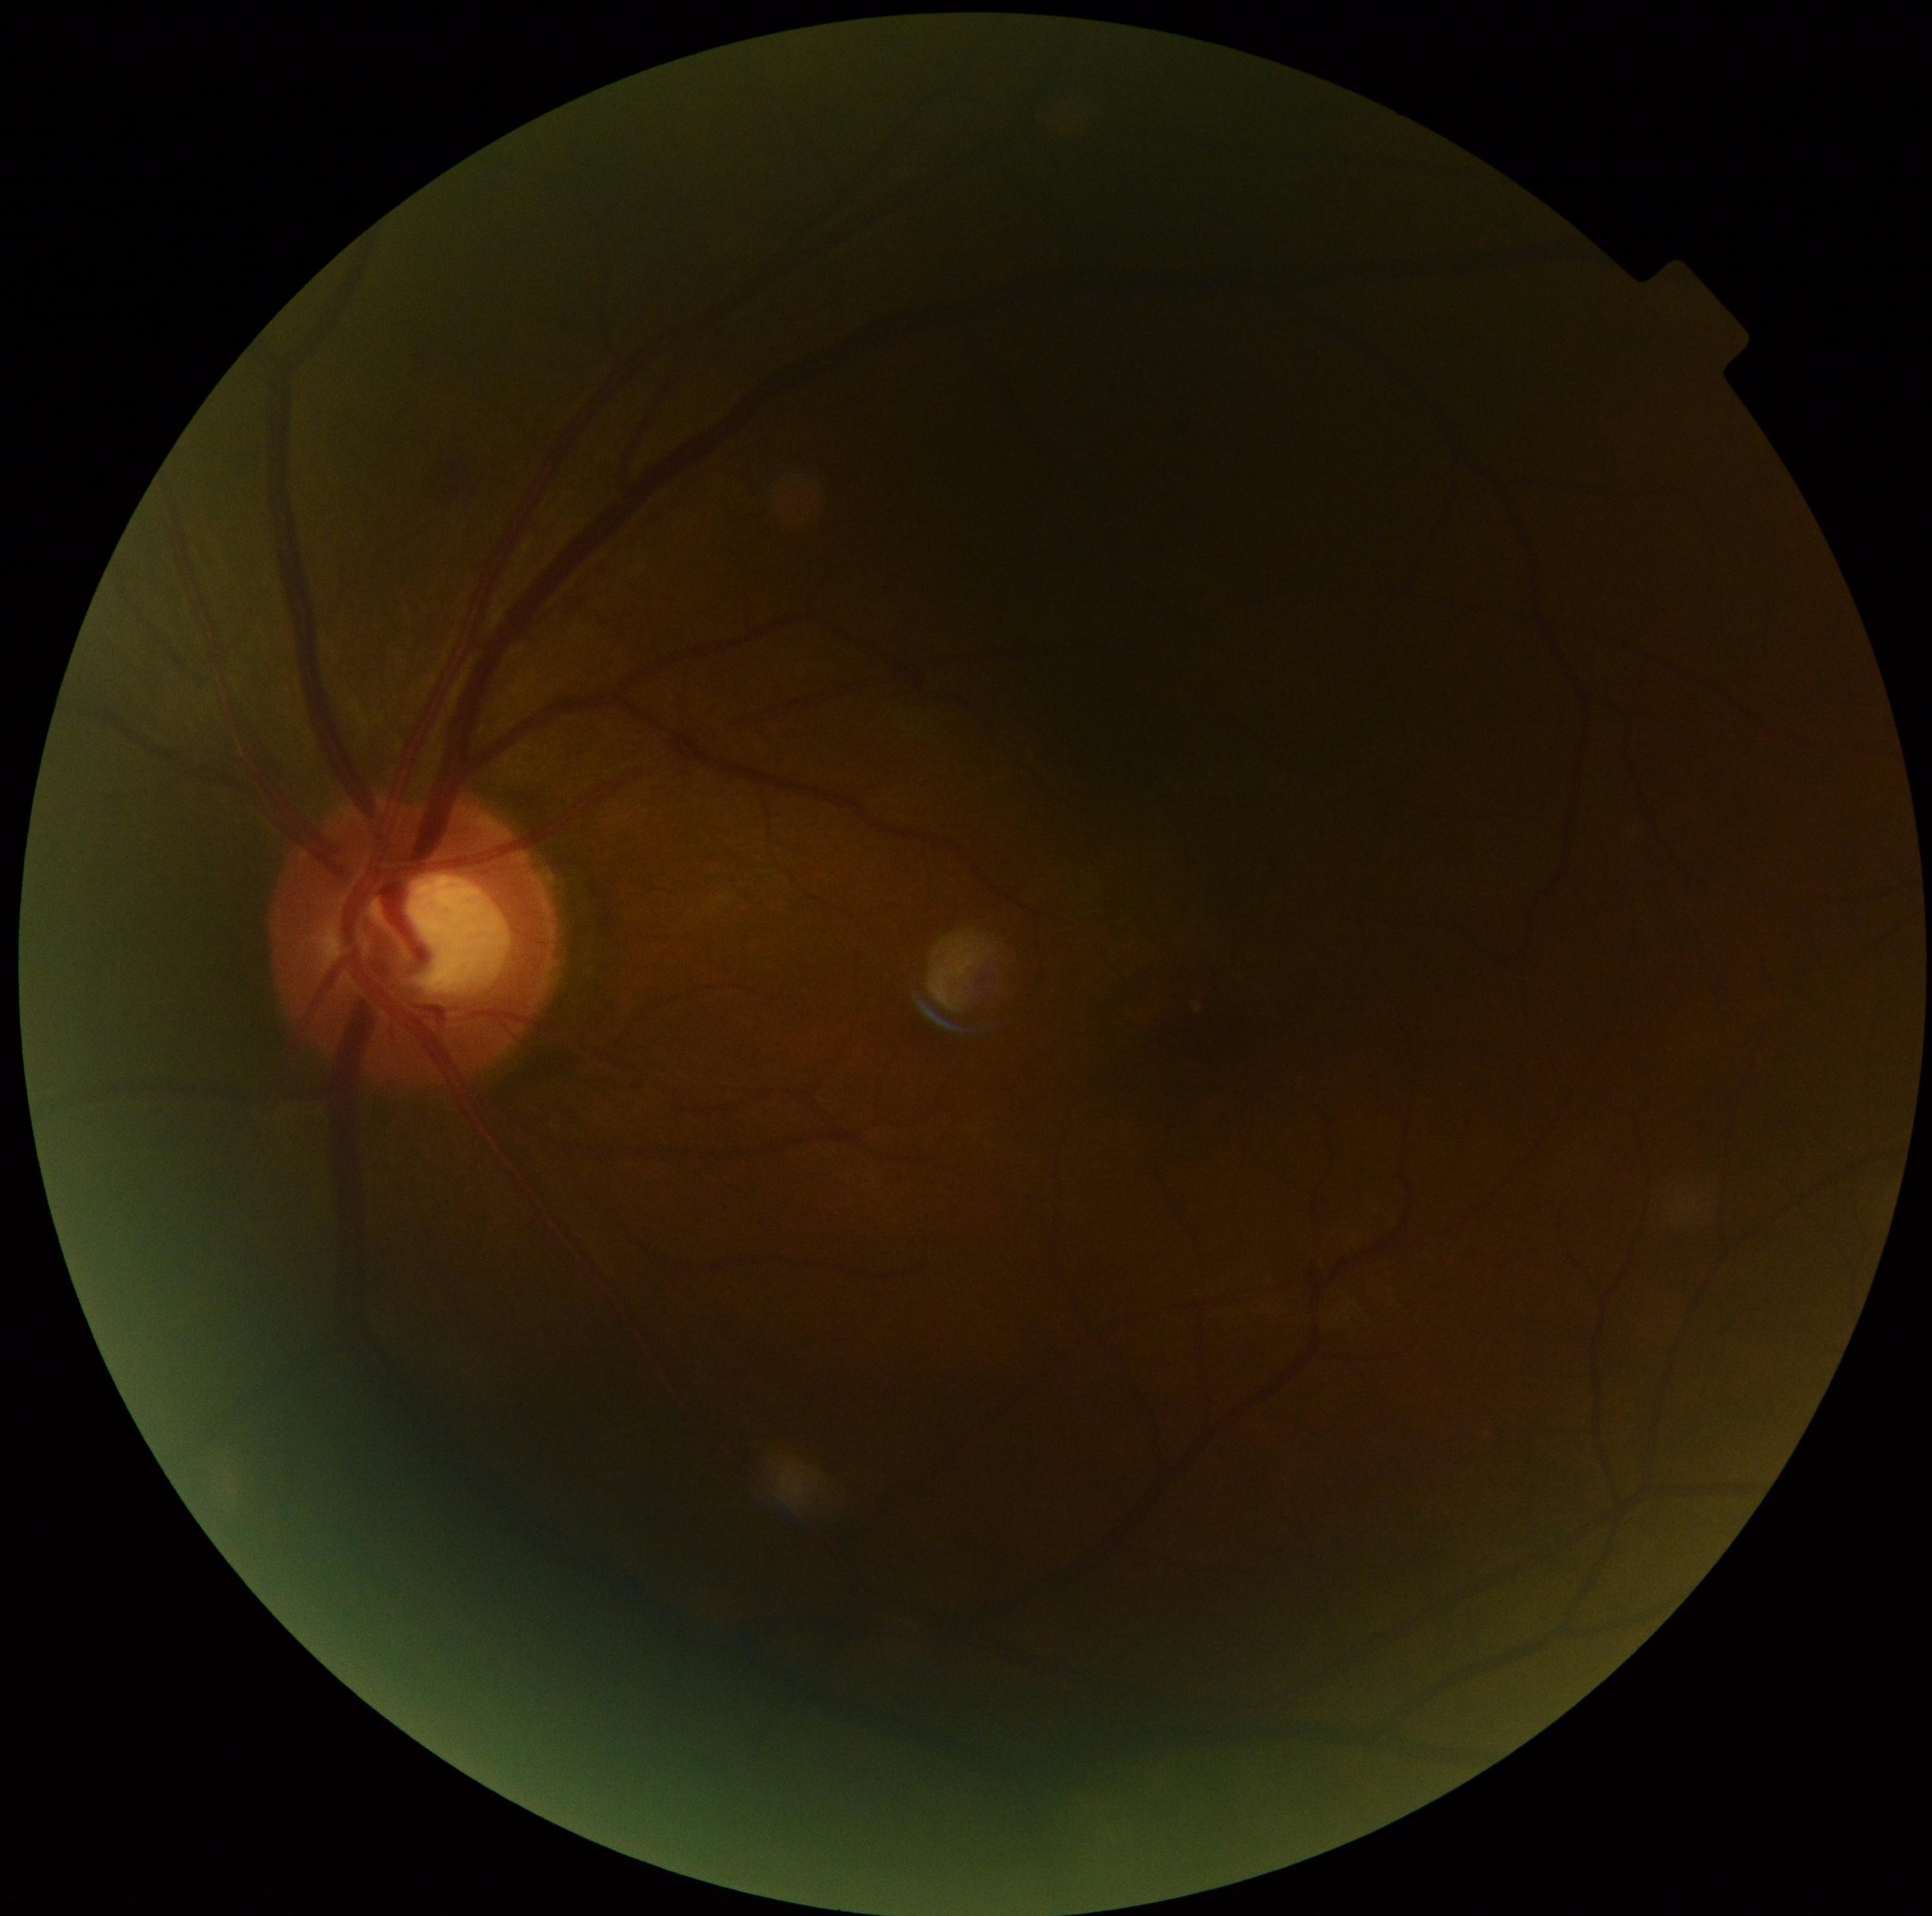
Diabetic retinopathy (DR): moderate NPDR (grade 2).